45 degree fundus photograph. Acquired with a NIDEK AFC-230. Image size 848x848. Without pupil dilation. CFP
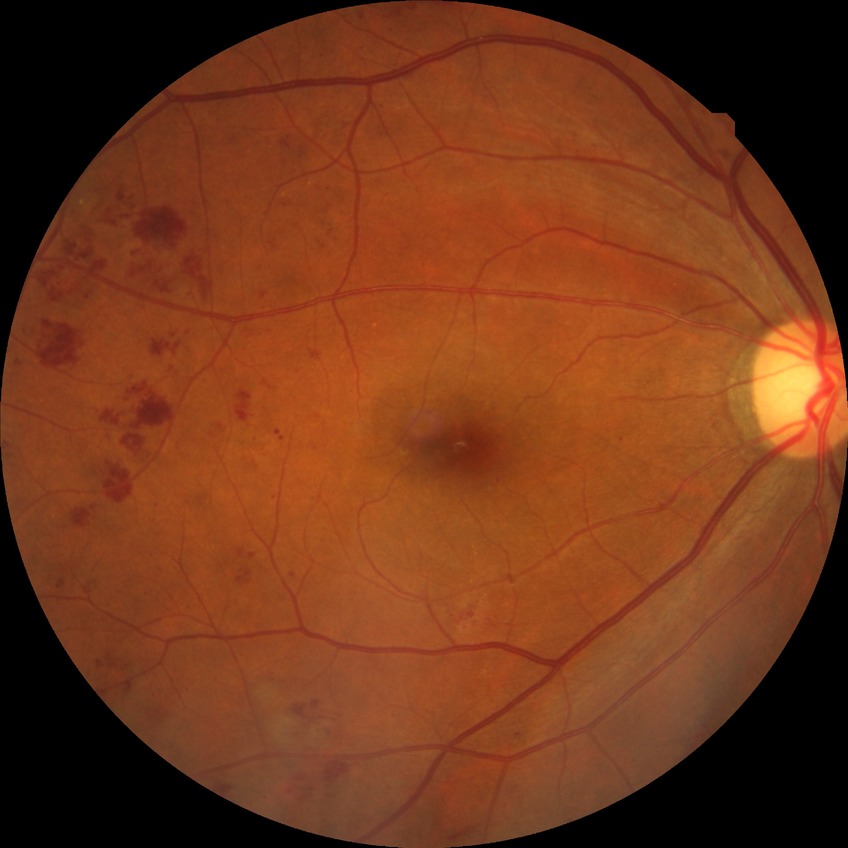 retinopathy stage@pre-proliferative diabetic retinopathy.